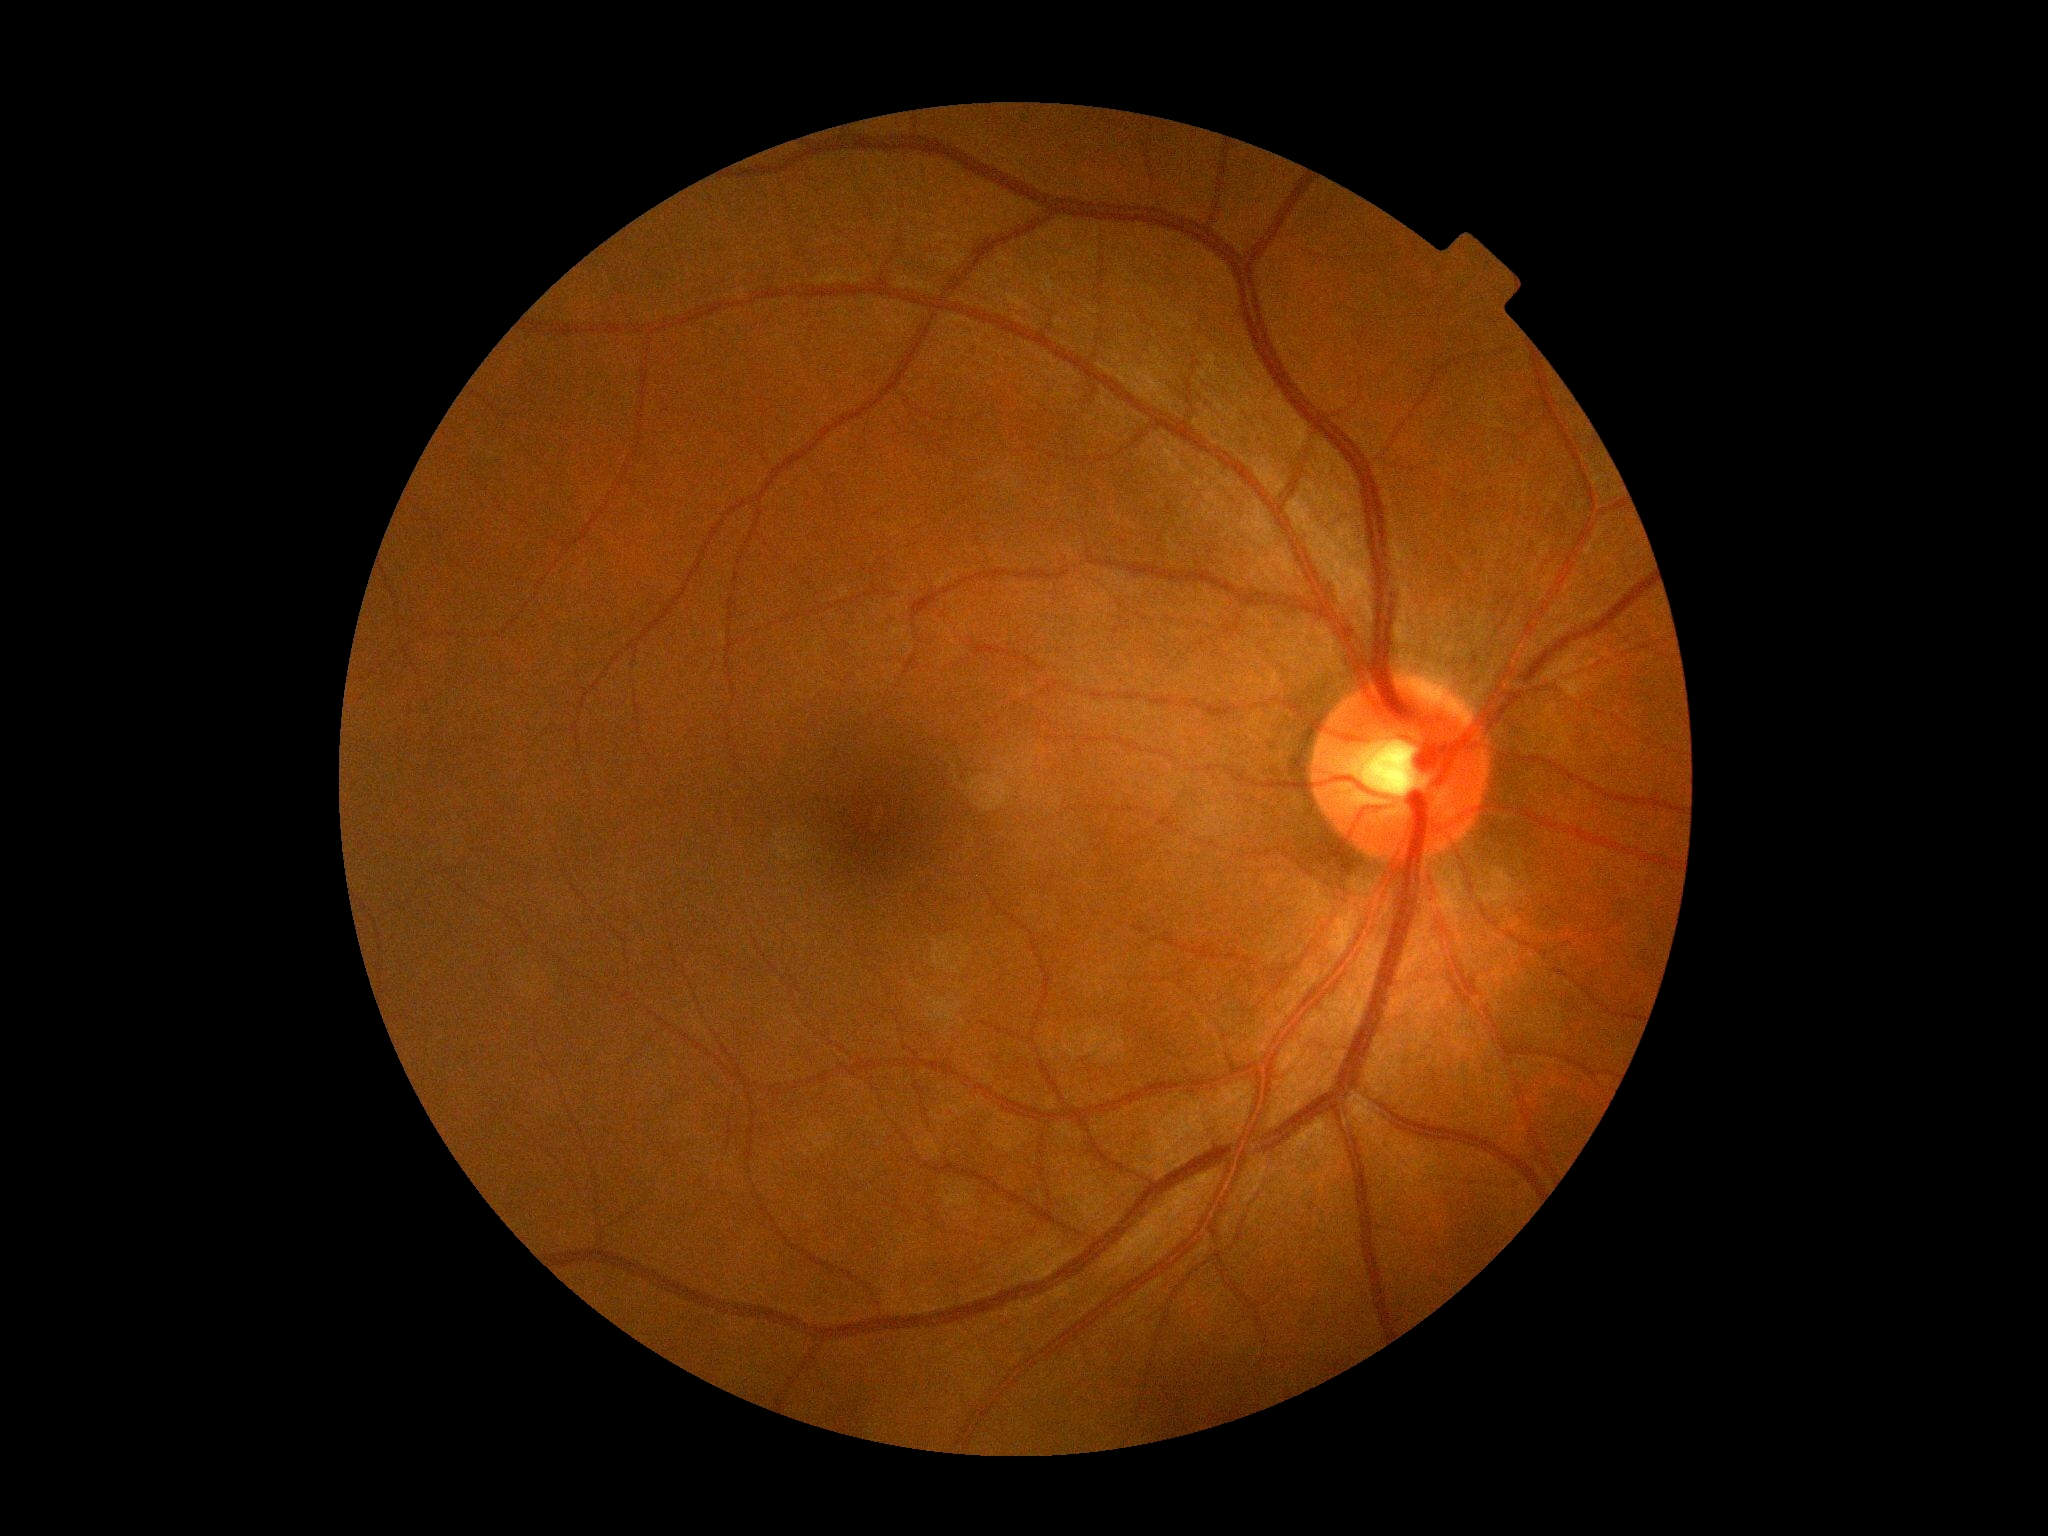 diabetic retinopathy grade@0 (no apparent retinopathy), DR impression@no apparent DR.